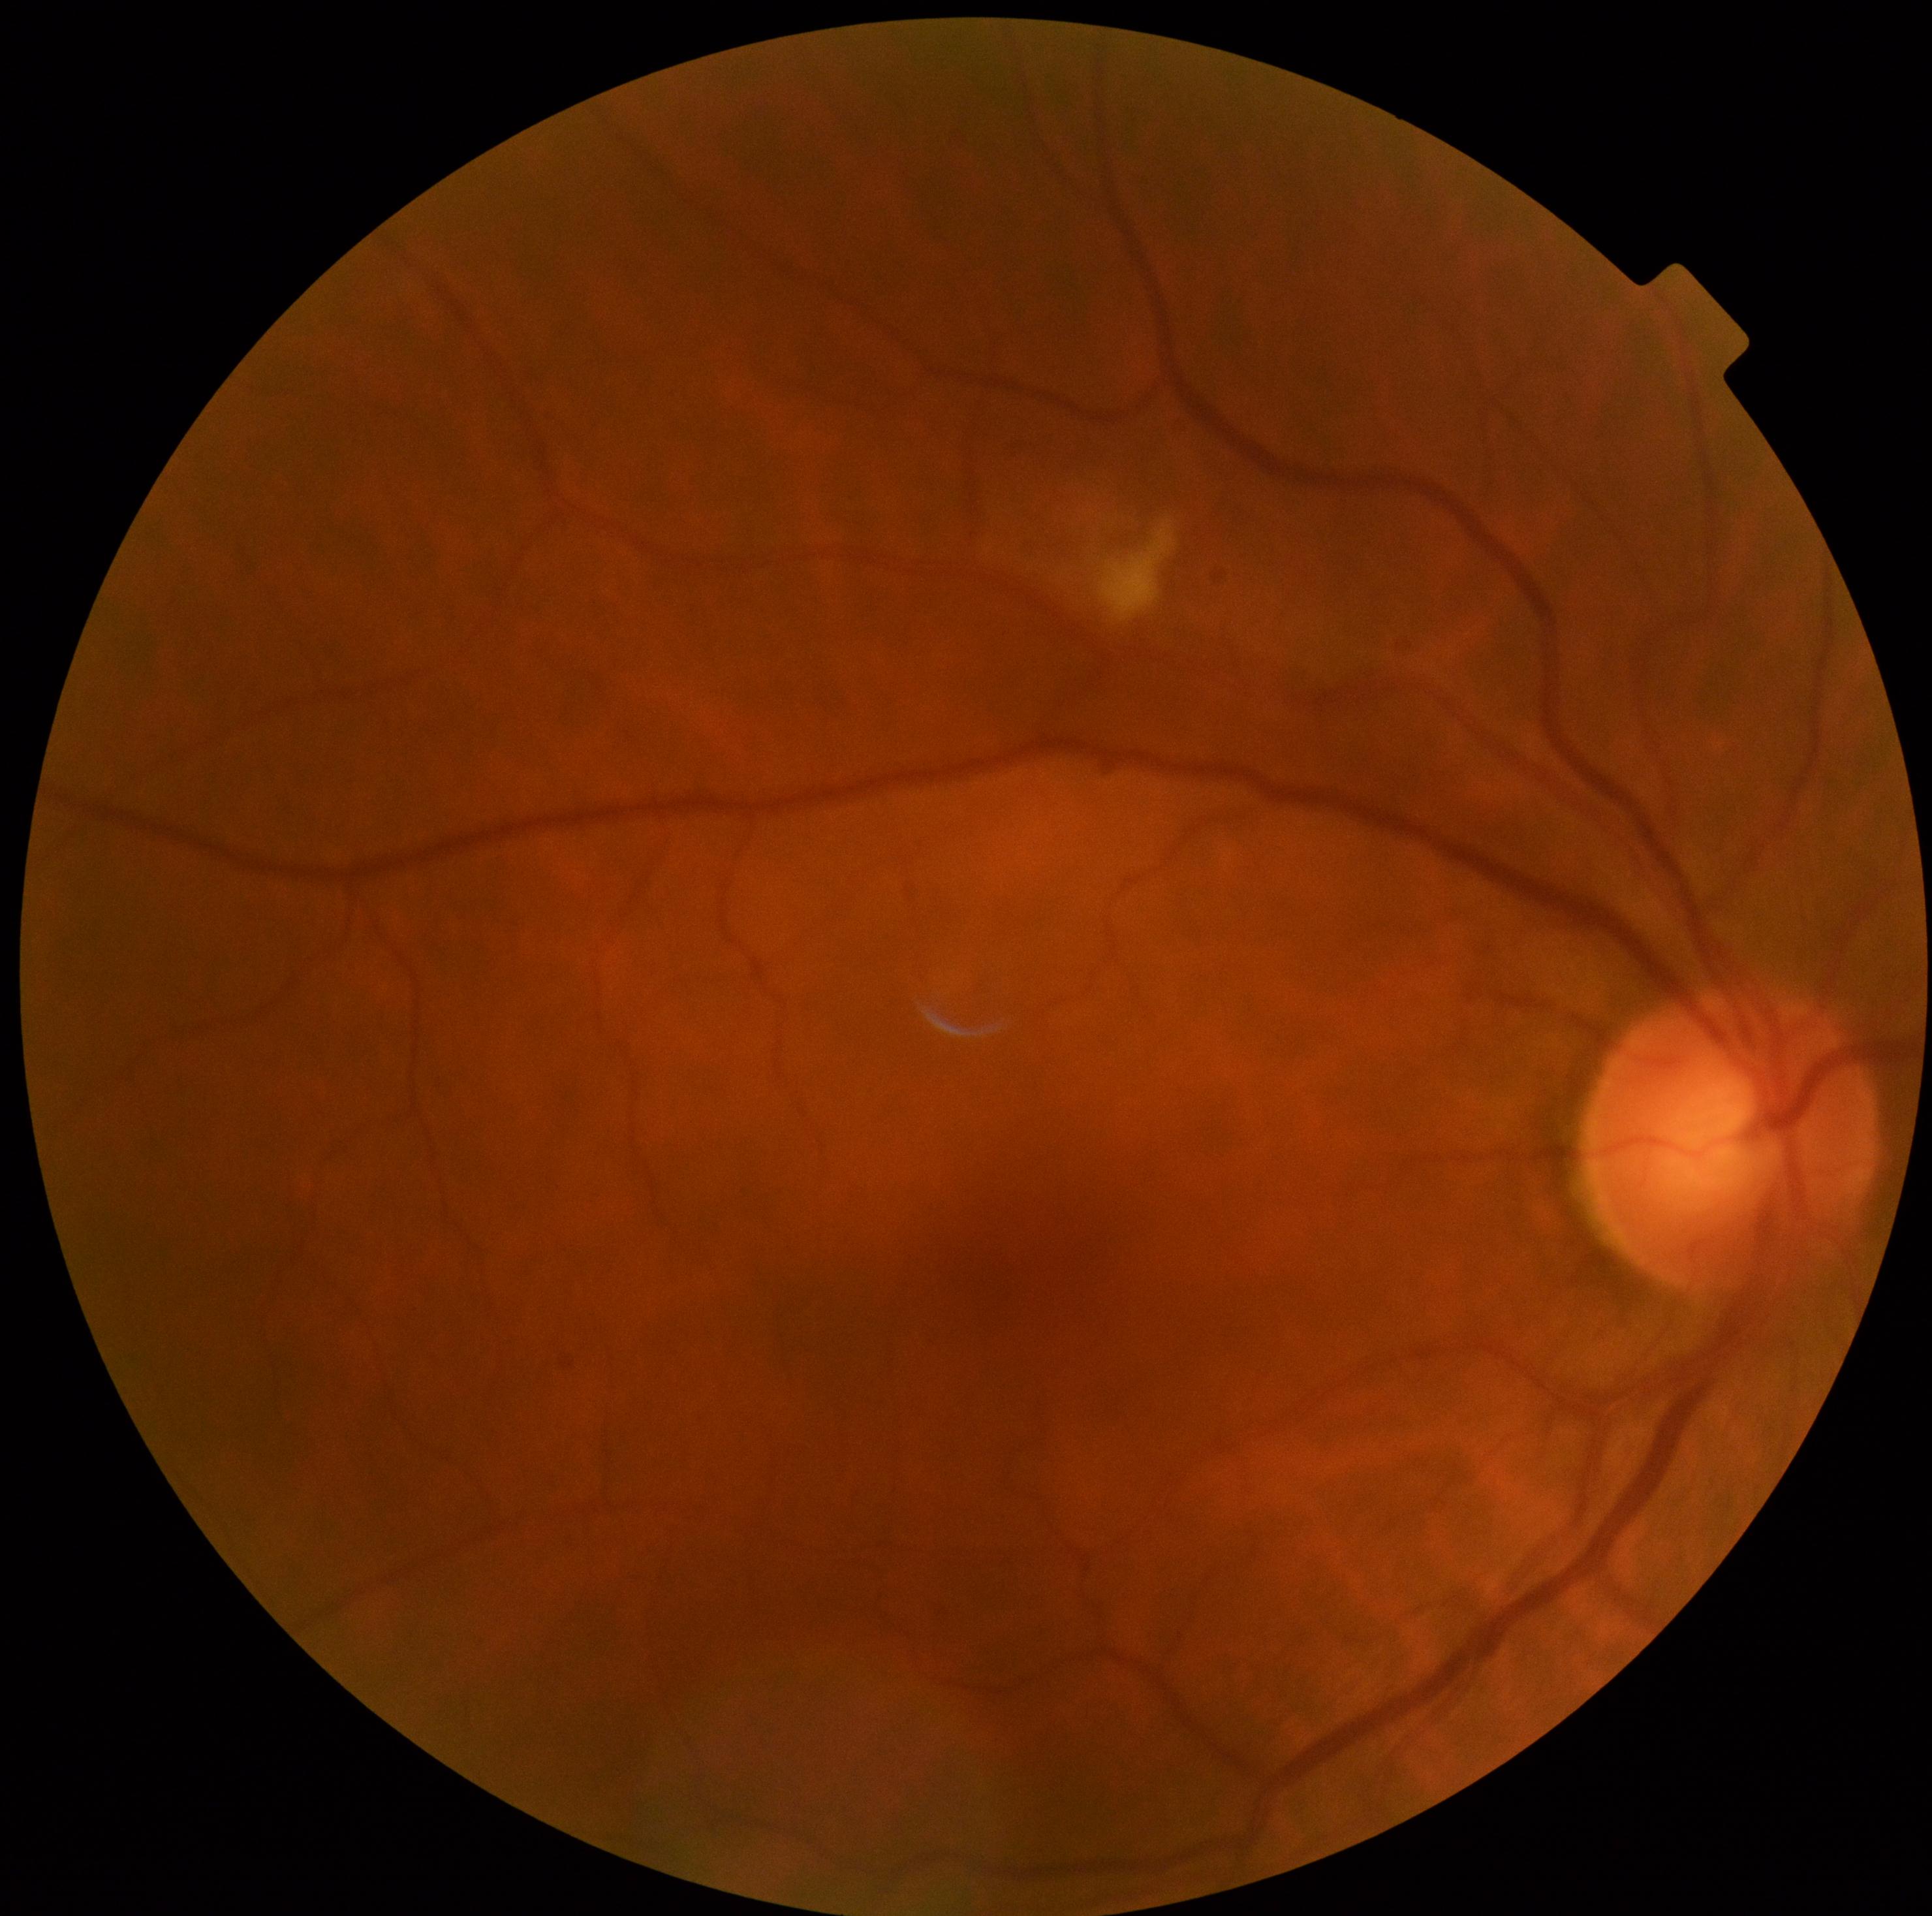 DR stage: moderate non-proliferative diabetic retinopathy (grade 2) — more than just microaneurysms but less than severe NPDR.